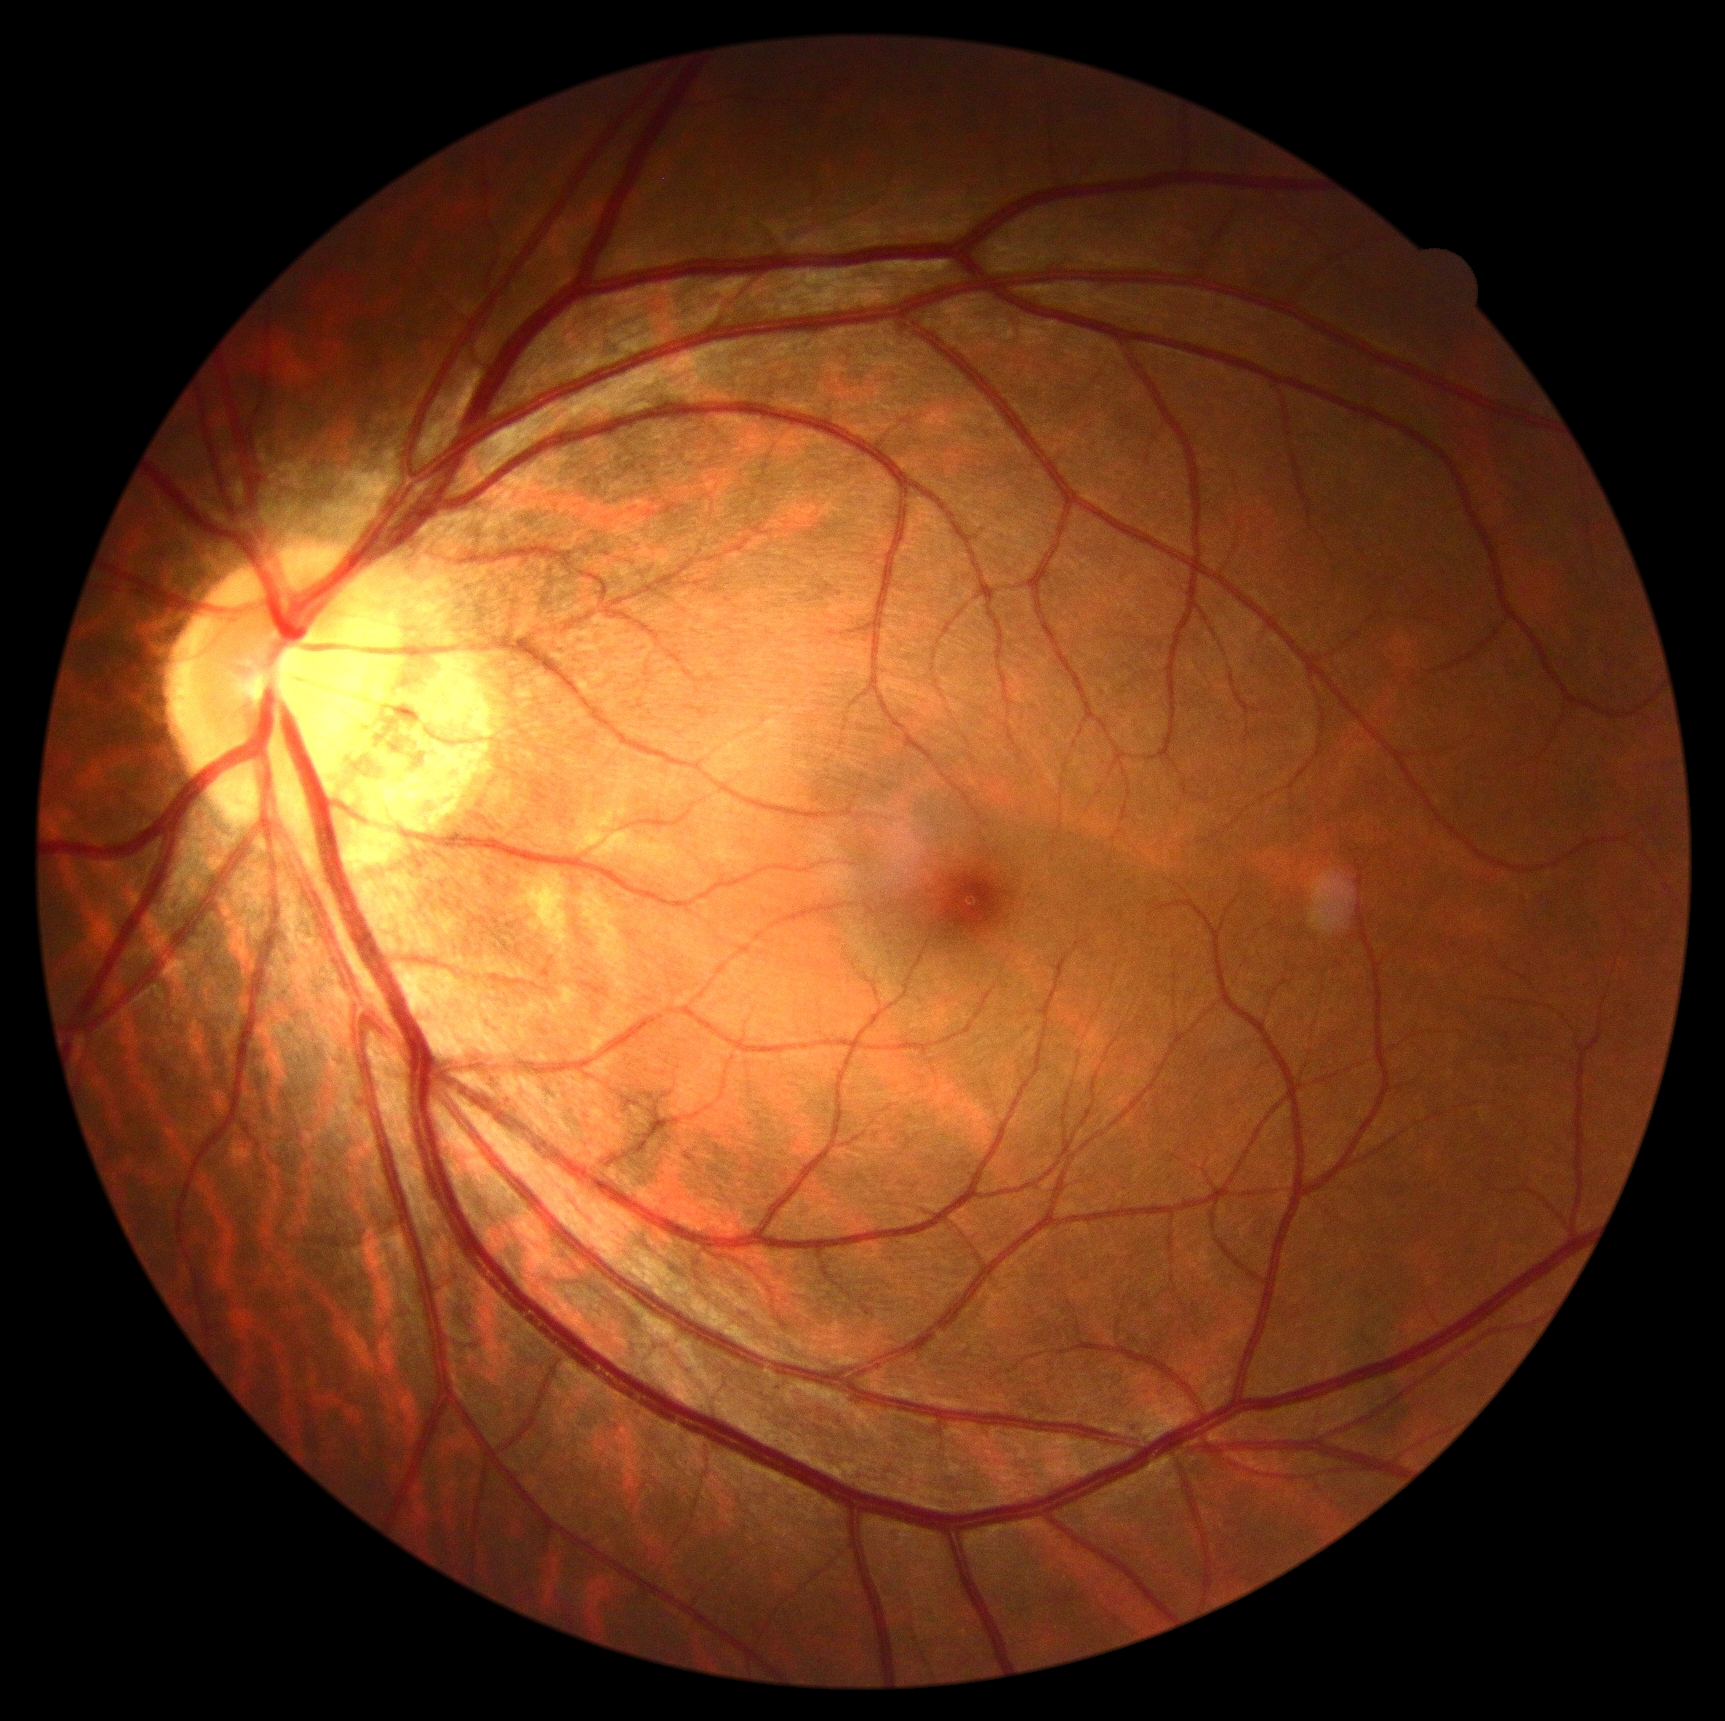
Findings:
* DR: grade 0 (no apparent retinopathy) — no visible signs of diabetic retinopathy
* DR impression: negative for DR